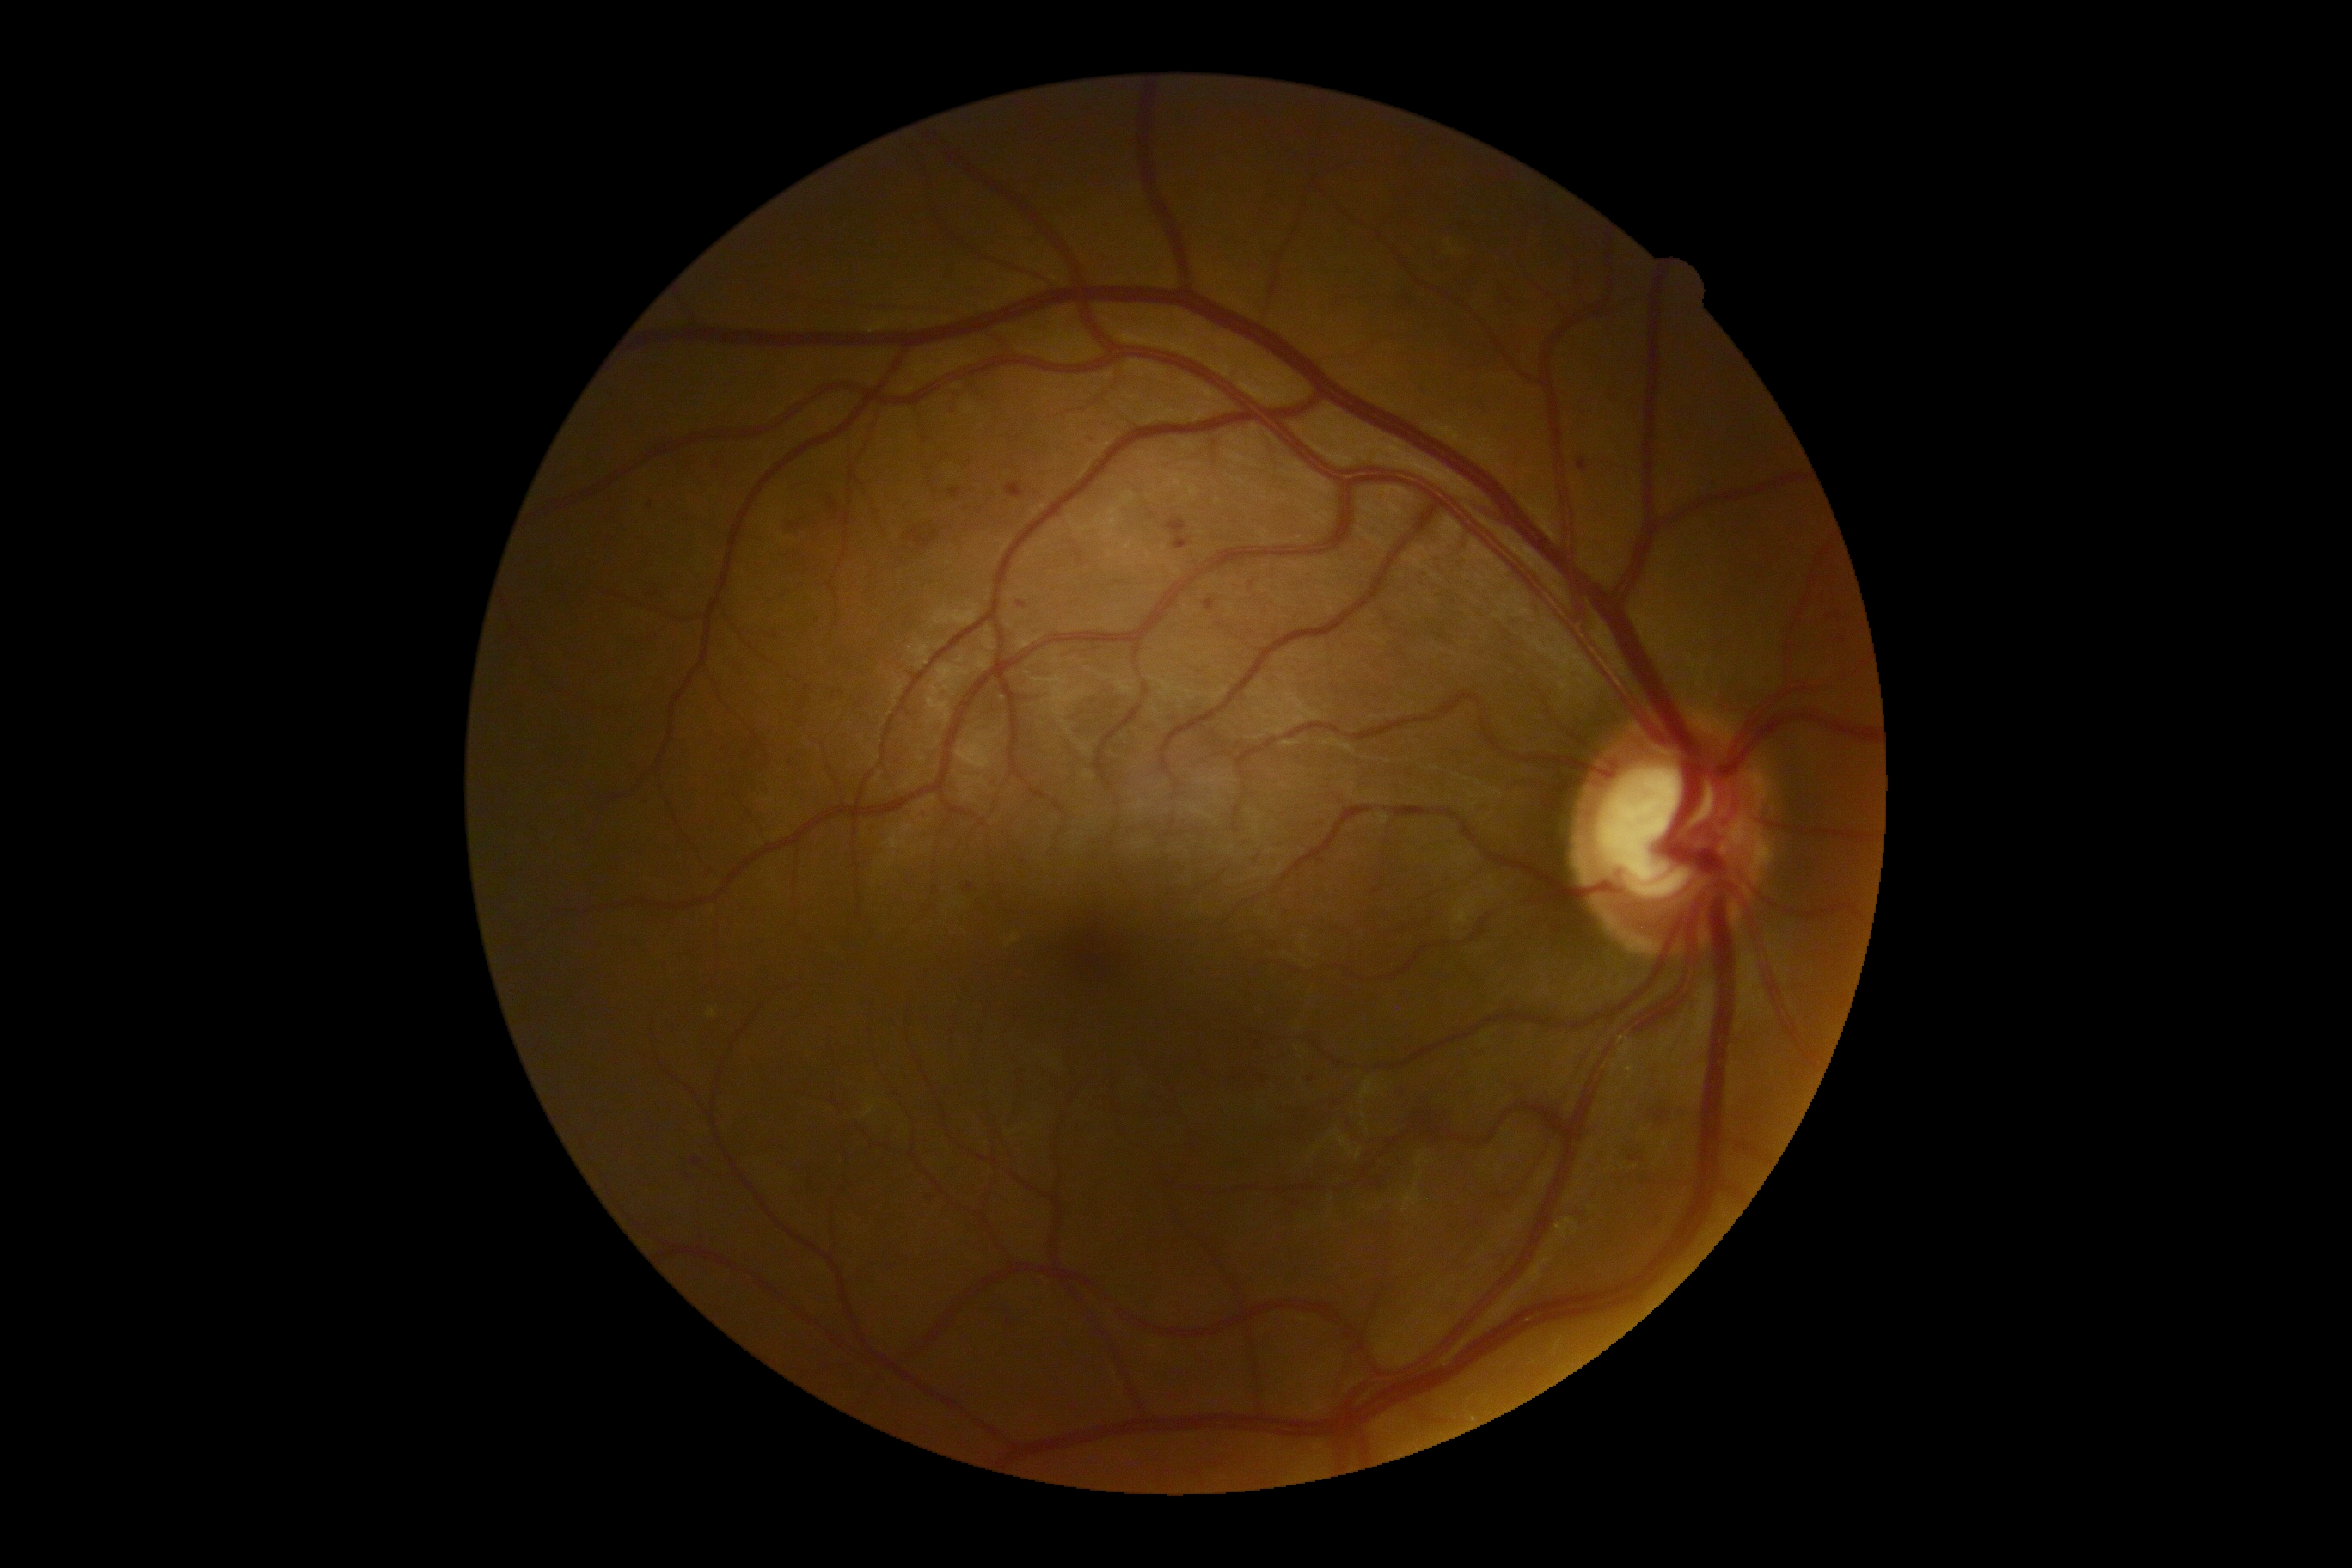

DR class=non-proliferative diabetic retinopathy; DR severity=grade 2.